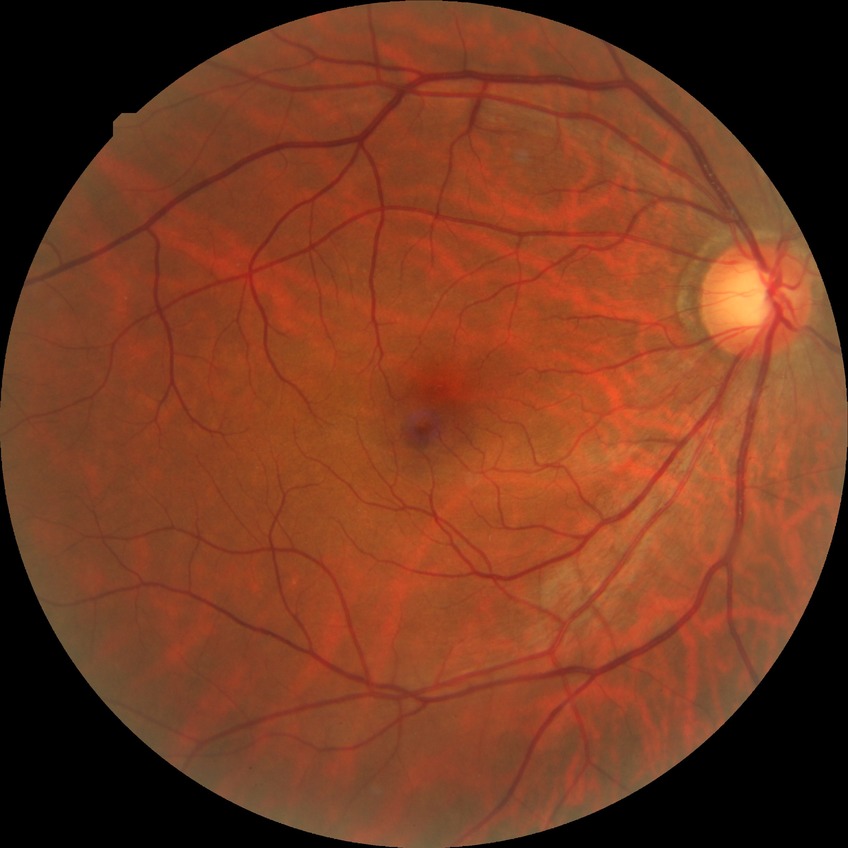
modified Davis classification=no diabetic retinopathy.